1240 x 1240 pixels. Wide-field fundus photograph from neonatal ROP screening:
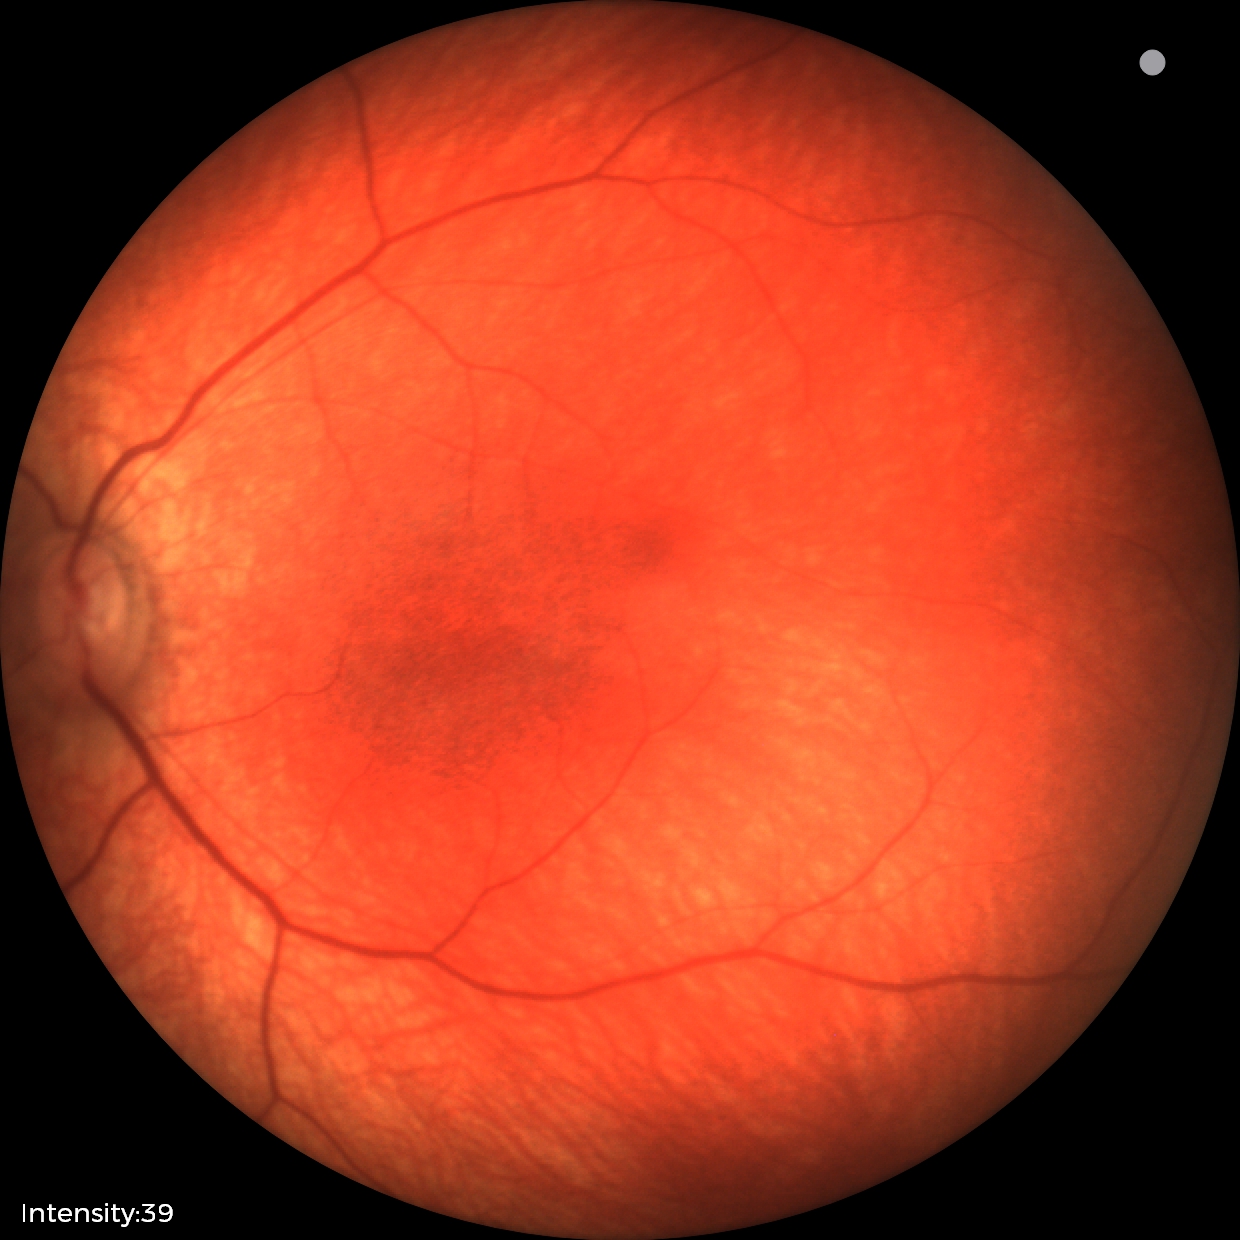

Assessment: physiological appearance